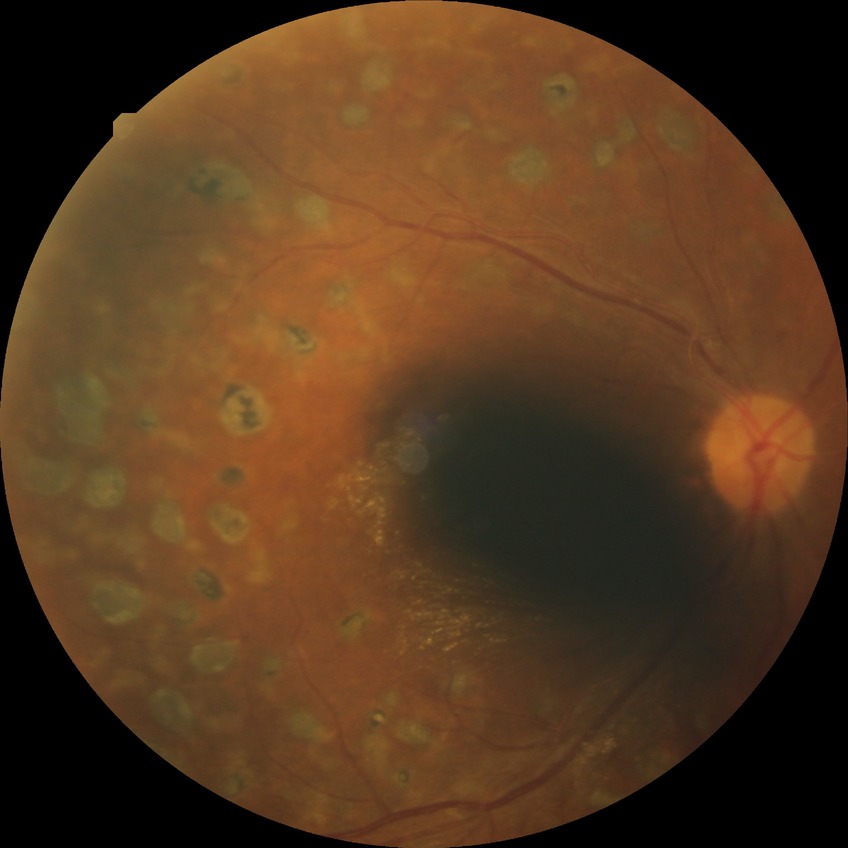
diabetic retinopathy (DR): proliferative diabetic retinopathy (PDR).